Image size 848x848 — 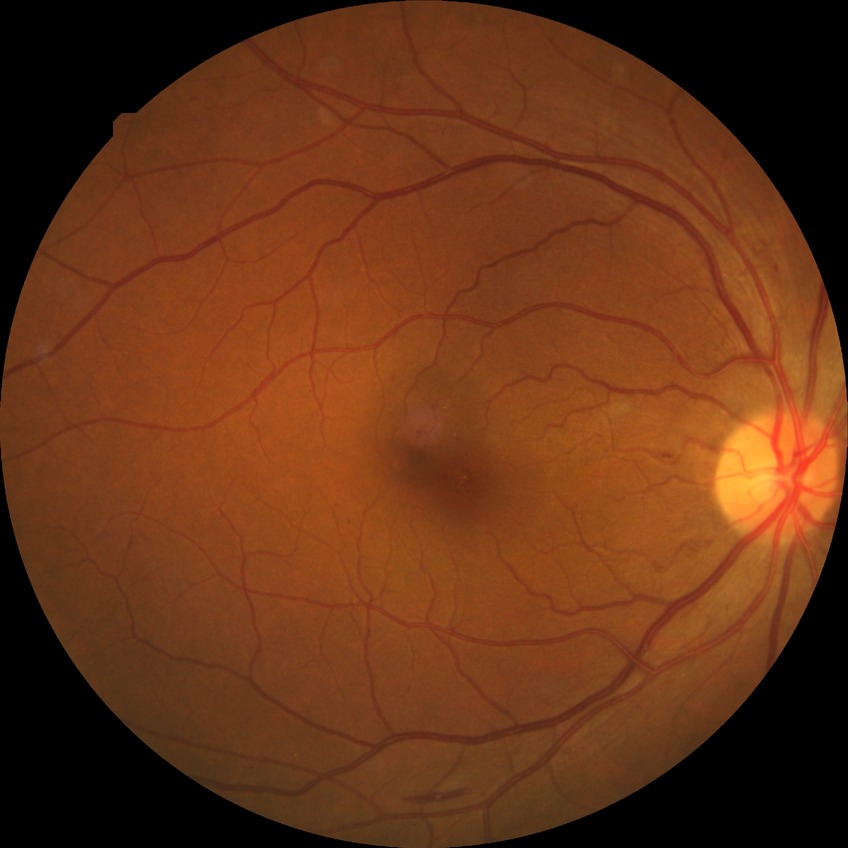 Diabetic retinopathy (DR): simple diabetic retinopathy (SDR).